2361 x 1568 pixels. Captured after pupil dilation. Color fundus image. Macula at the center of the field — 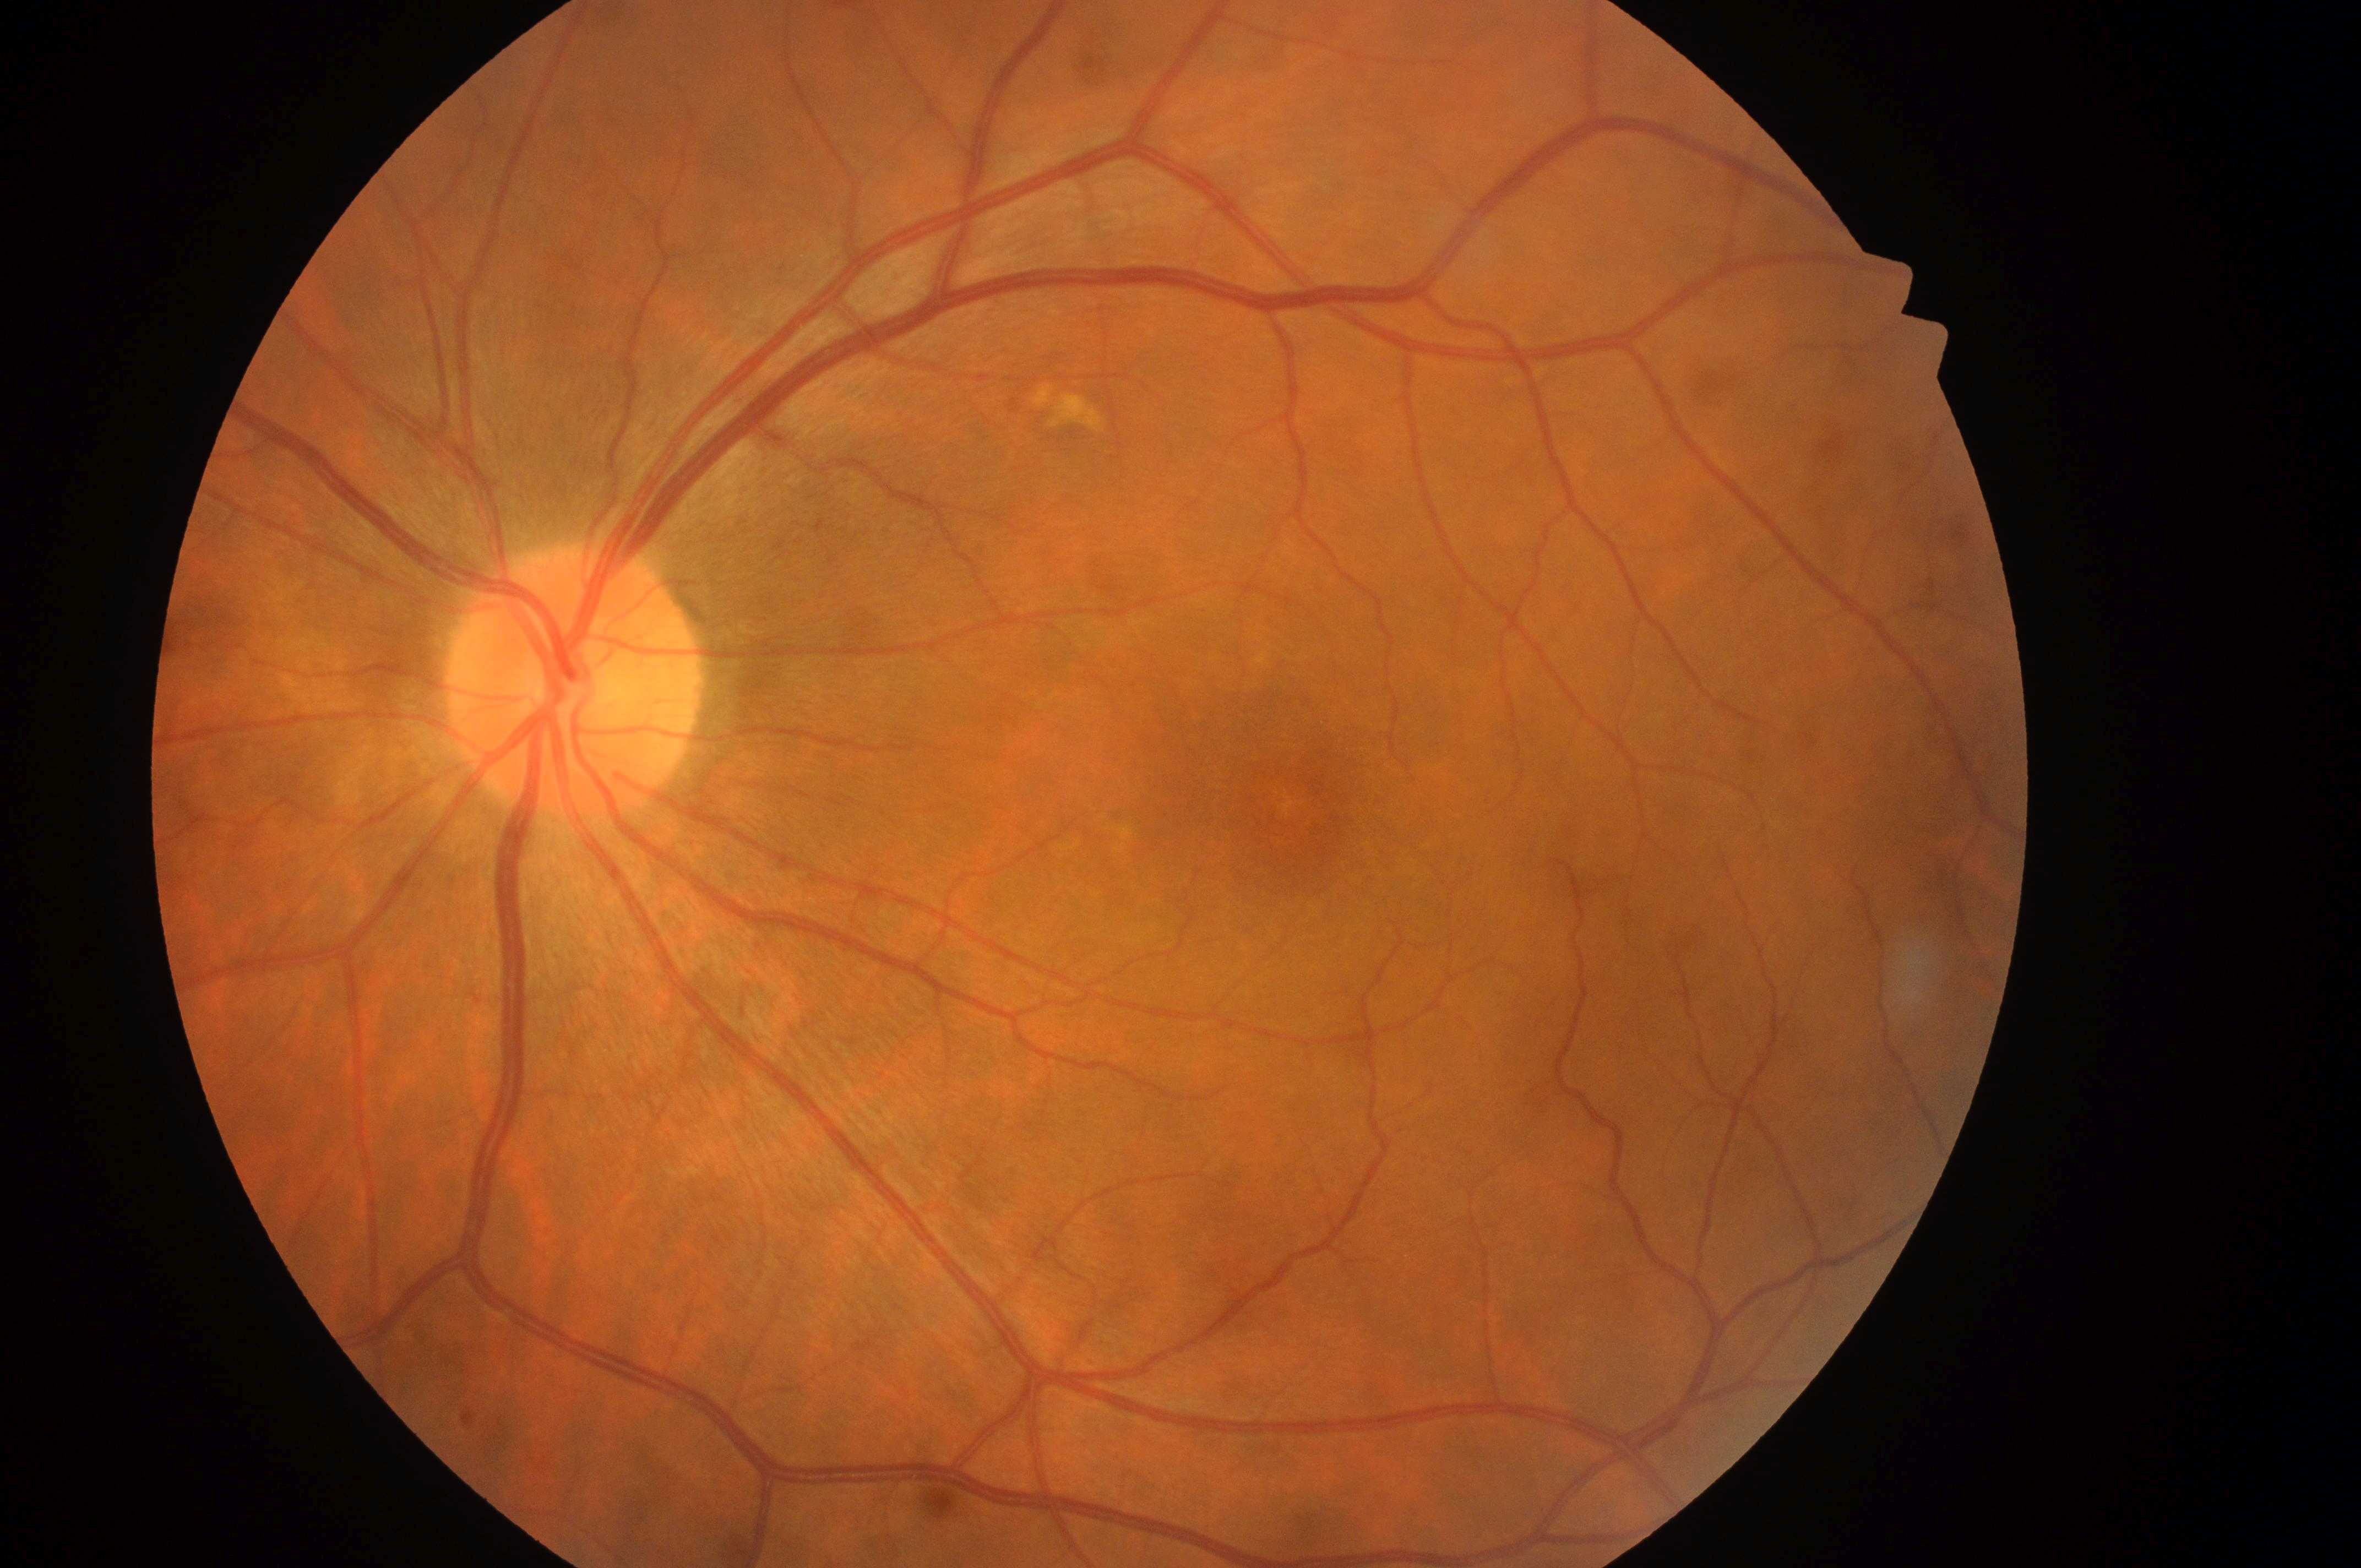 Annotations:
• DME: grade 0
• laterality: the left eye
• fovea: (1299, 823)
• disc center: (569, 694)
• DR severity: grade 0